NIDEK AFC-230 fundus camera.
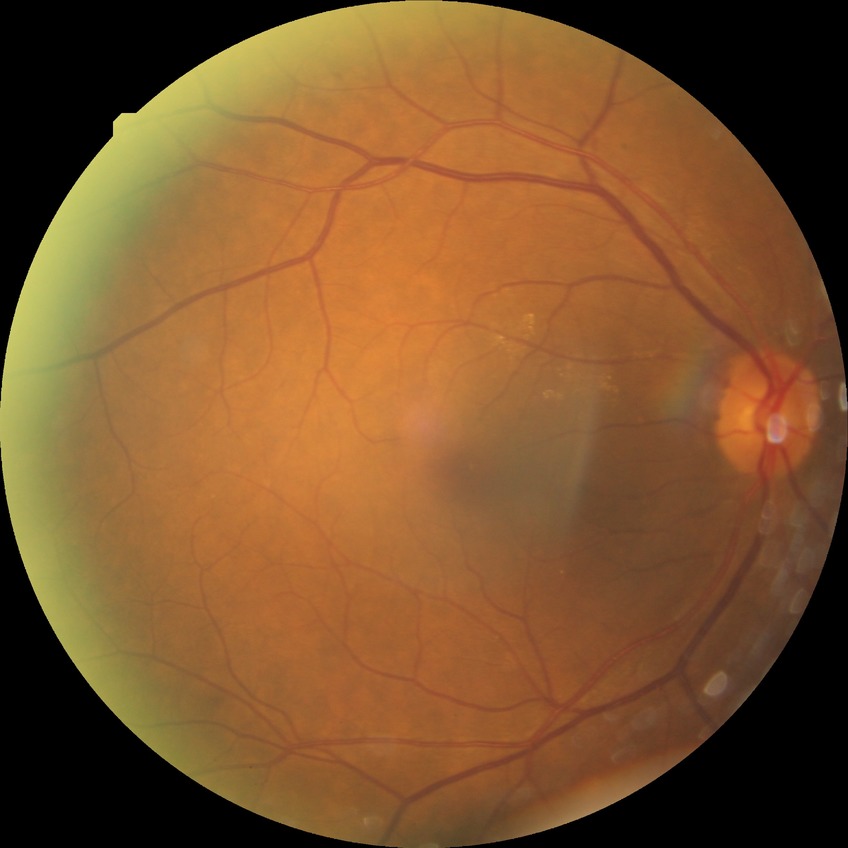

DR = SDR.